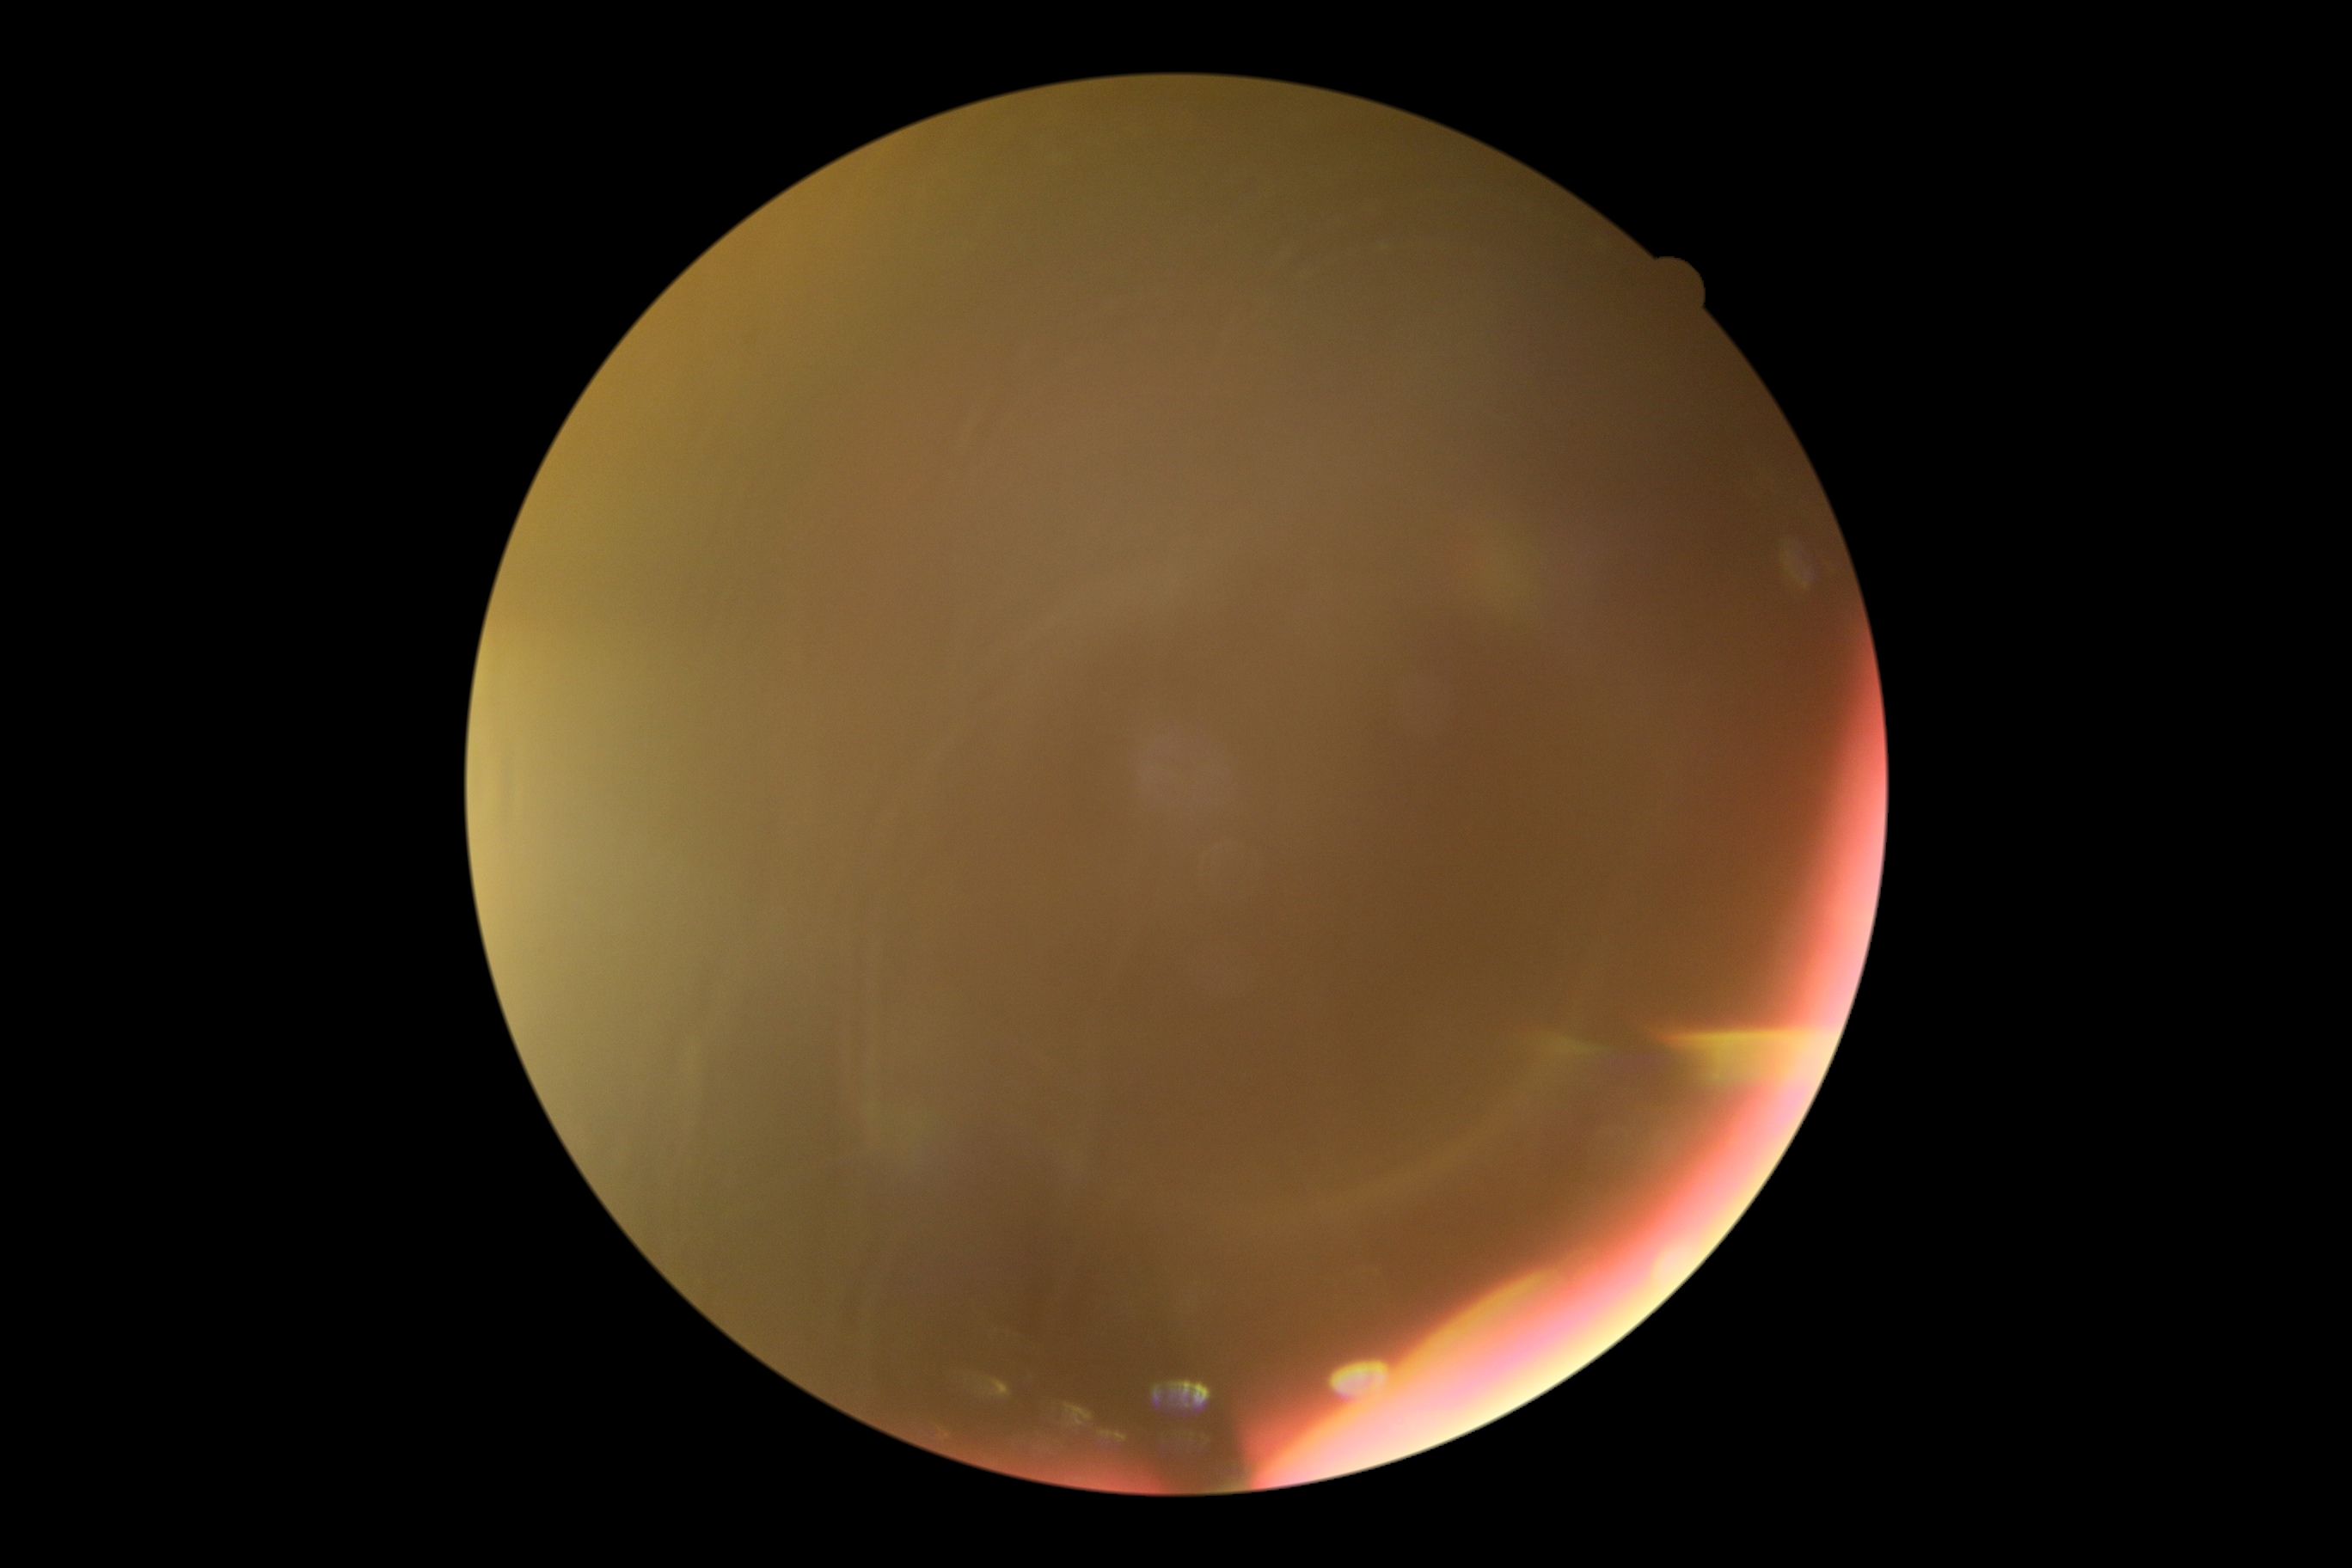 The image cannot be graded for diabetic retinopathy. Retinopathy grade: ungradable due to poor image quality.